1924 by 1556 pixels; ultra-widefield (UWF) fundus image
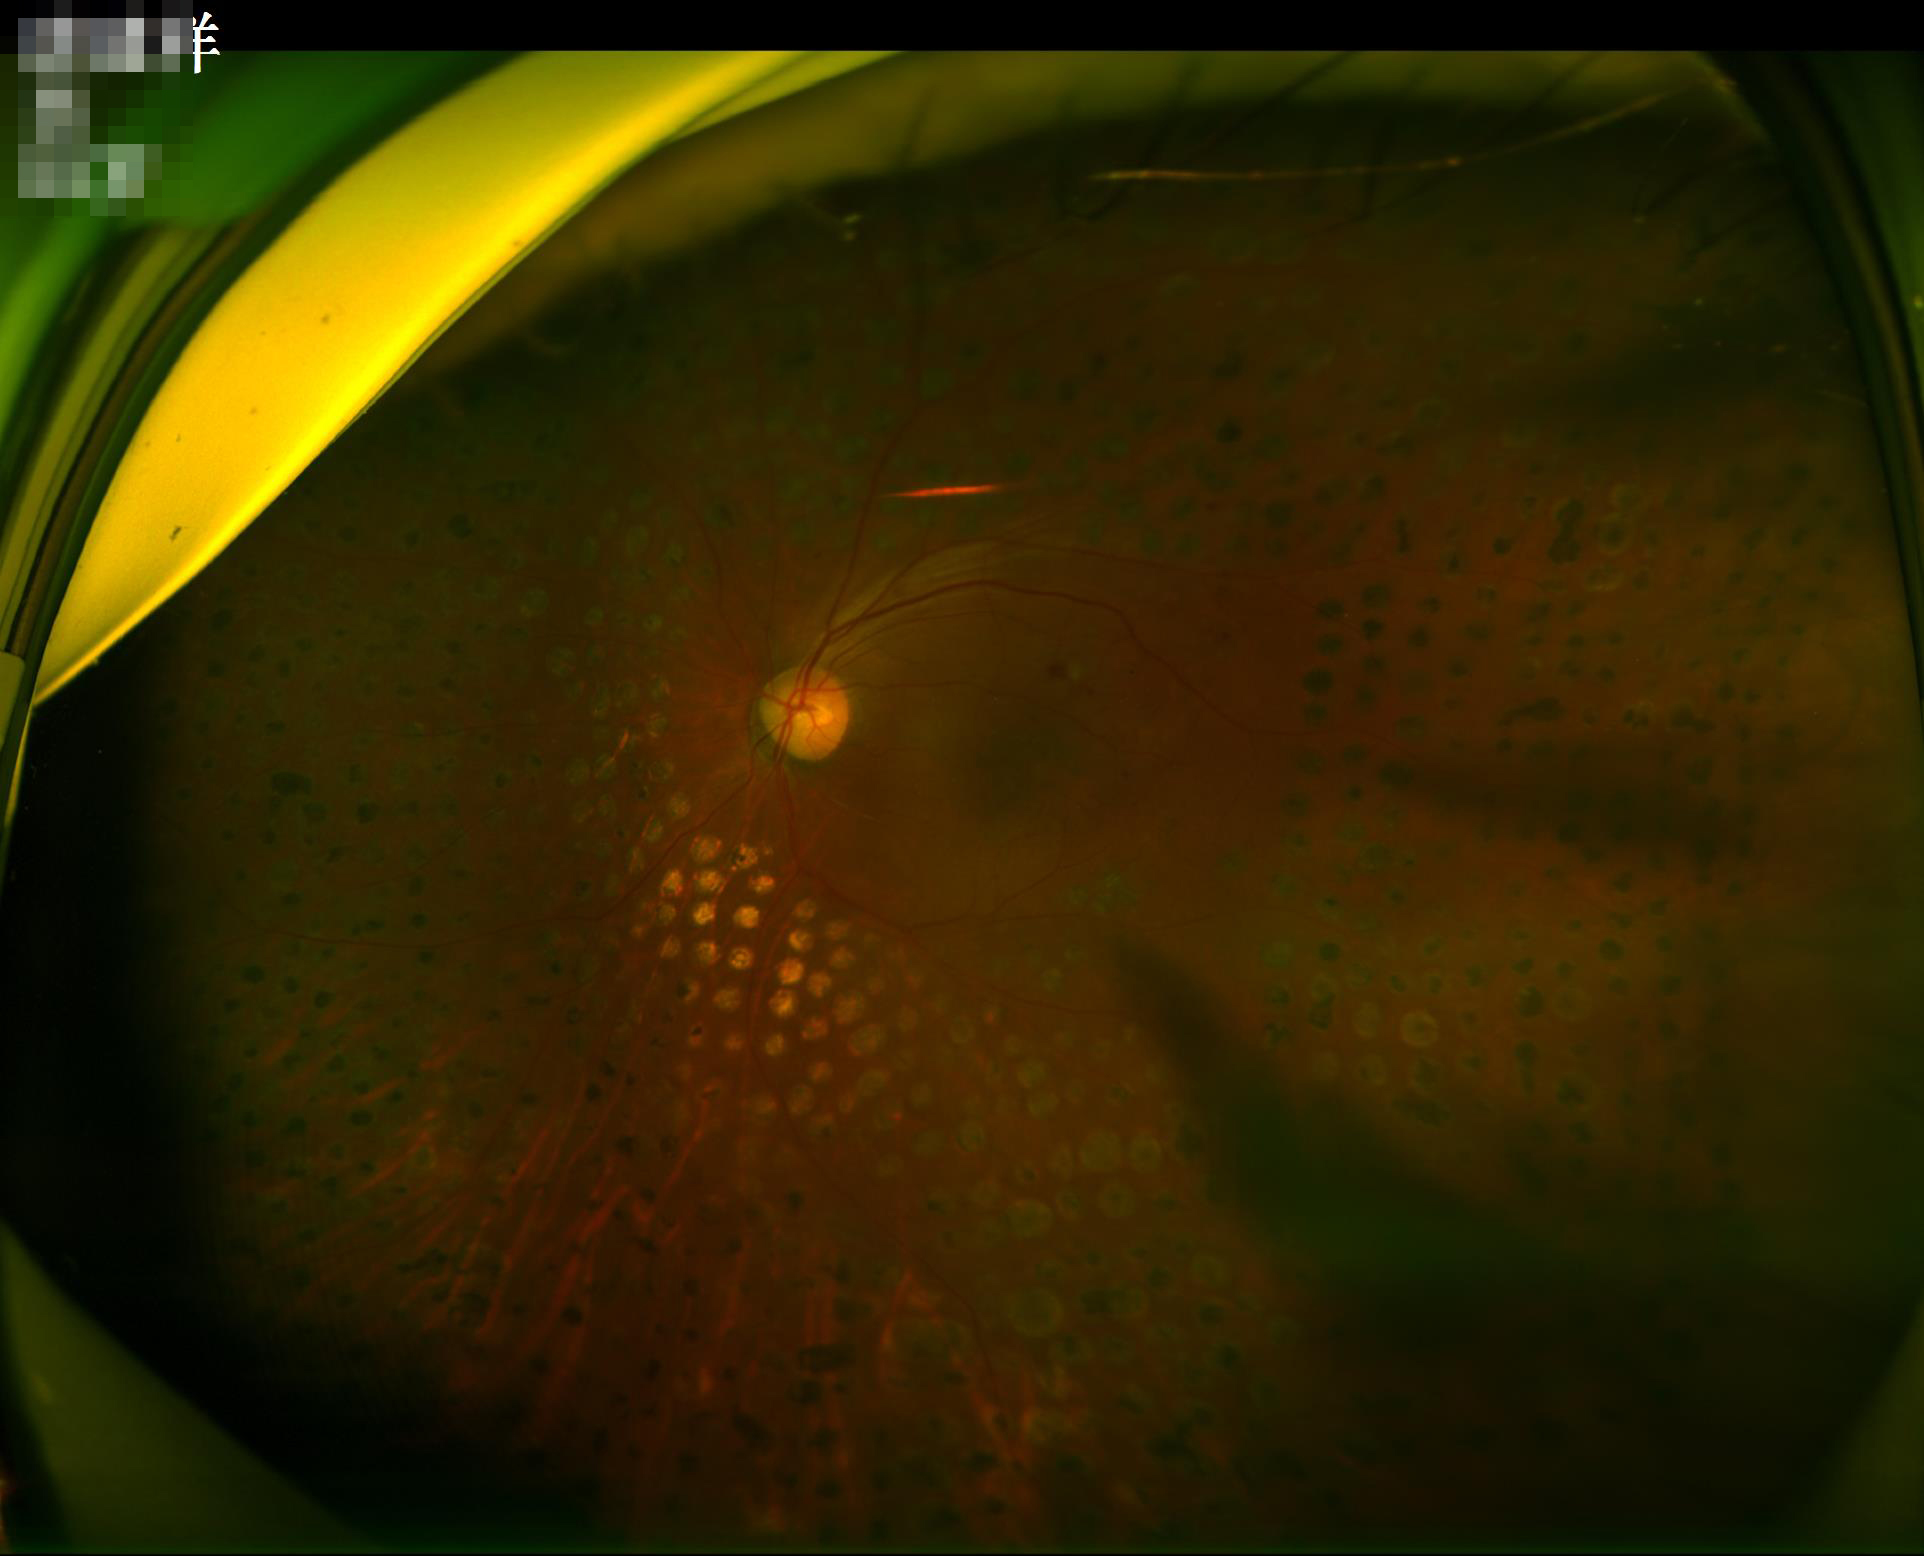 Focus: reduced
Overall quality: suboptimal
Illumination/color: uneven
Contrast: low